FOV: 50 degrees, tabletop color fundus camera image, 2361 by 1568 pixels:
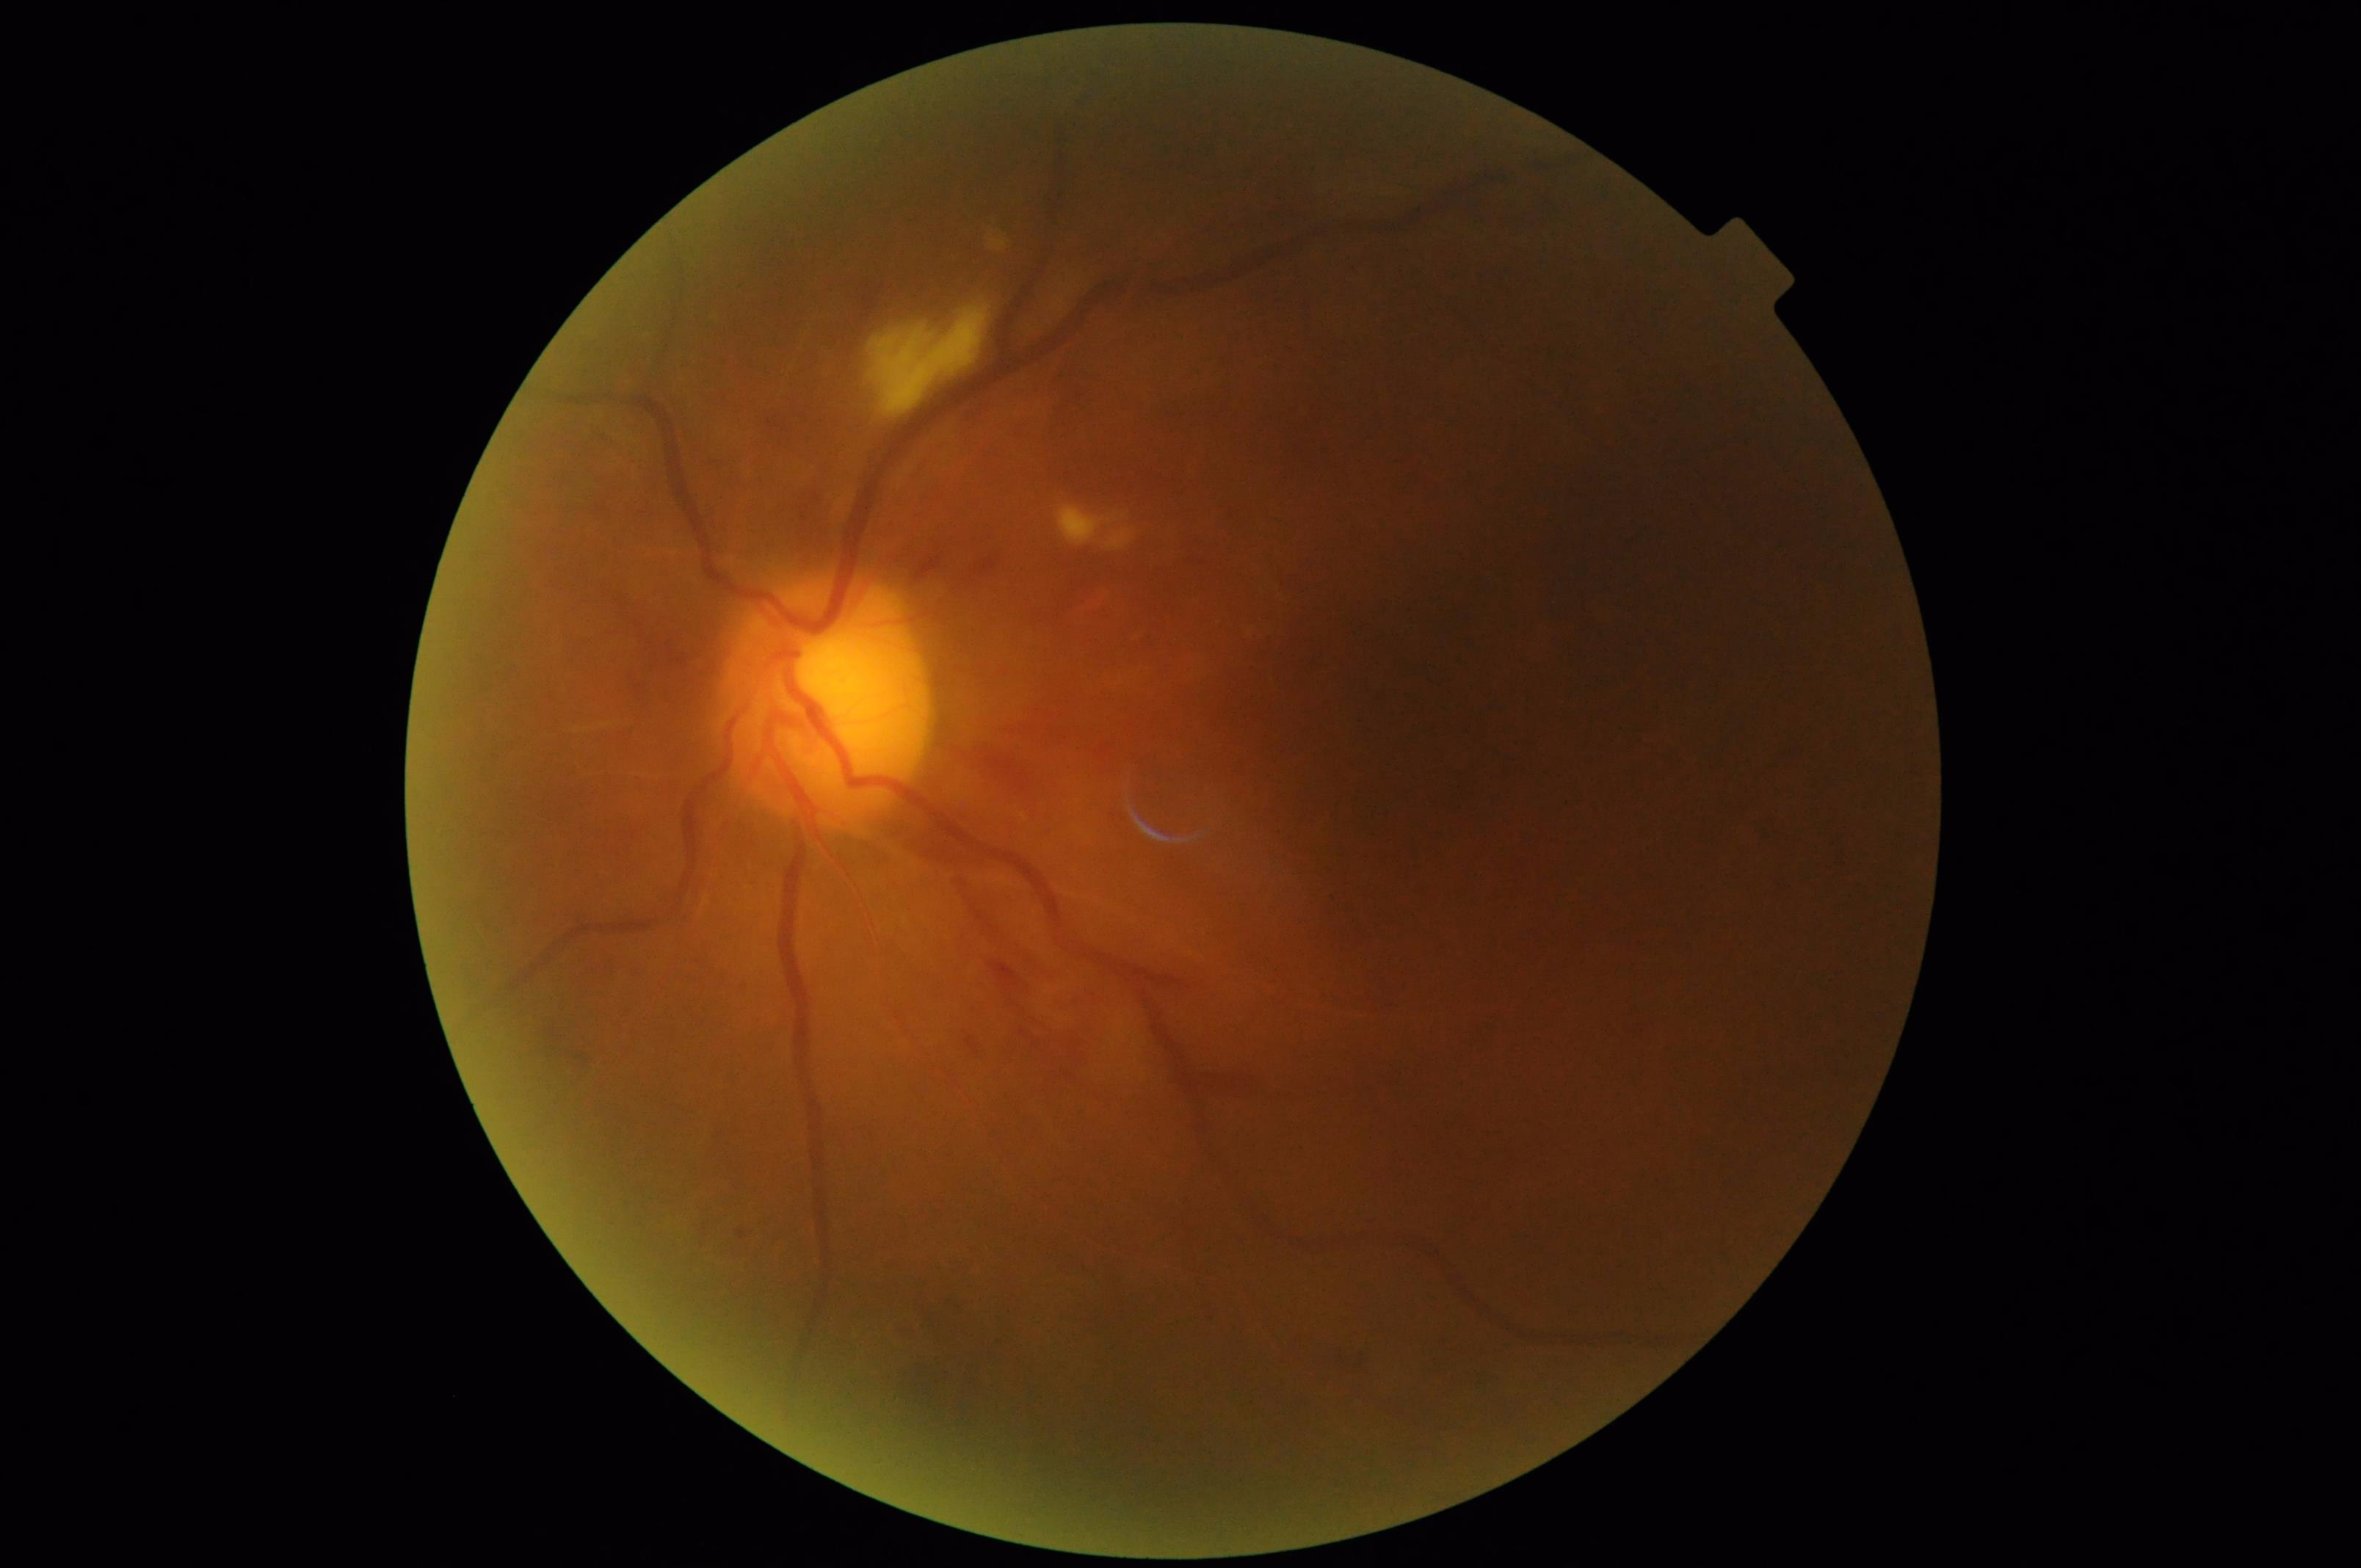 Illumination/color = inadequate, with uneven exposure or color distortion
Focus = optic disc, vessels, and background in focus
Contrast = wide intensity range, structures distinguishable
Overall = poor, ungradable